Nonmydriatic, color fundus image, 45° field of view, camera: NIDEK AFC-230
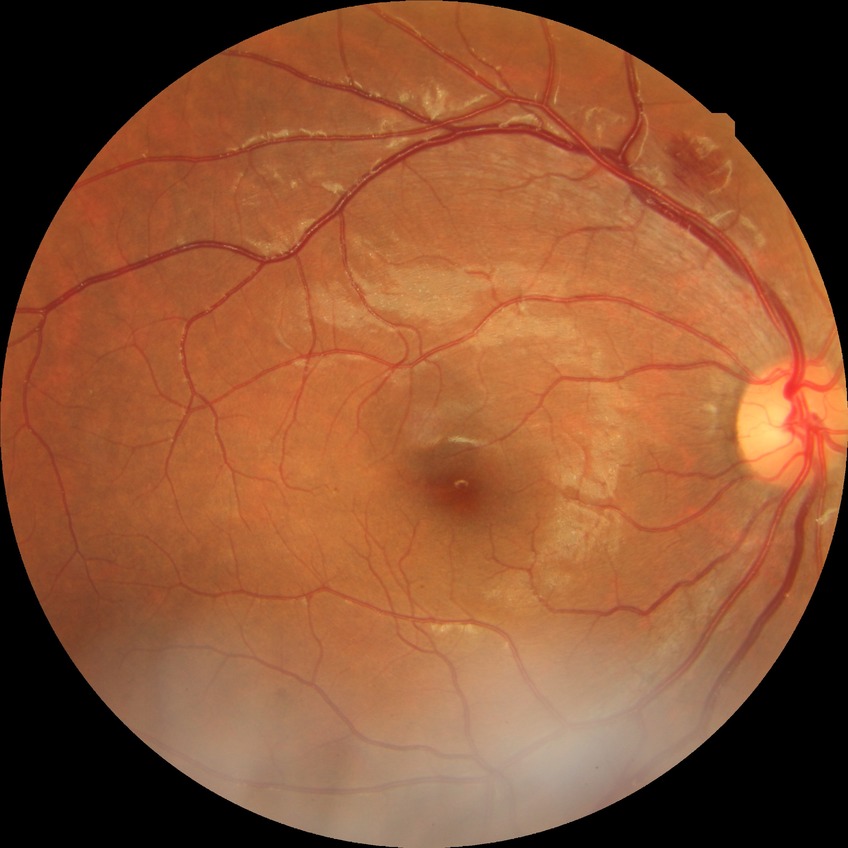

  davis_grade: SDR (simple diabetic retinopathy)